Posterior pole photograph. Without pupil dilation. 45° field of view. Modified Davis grading: 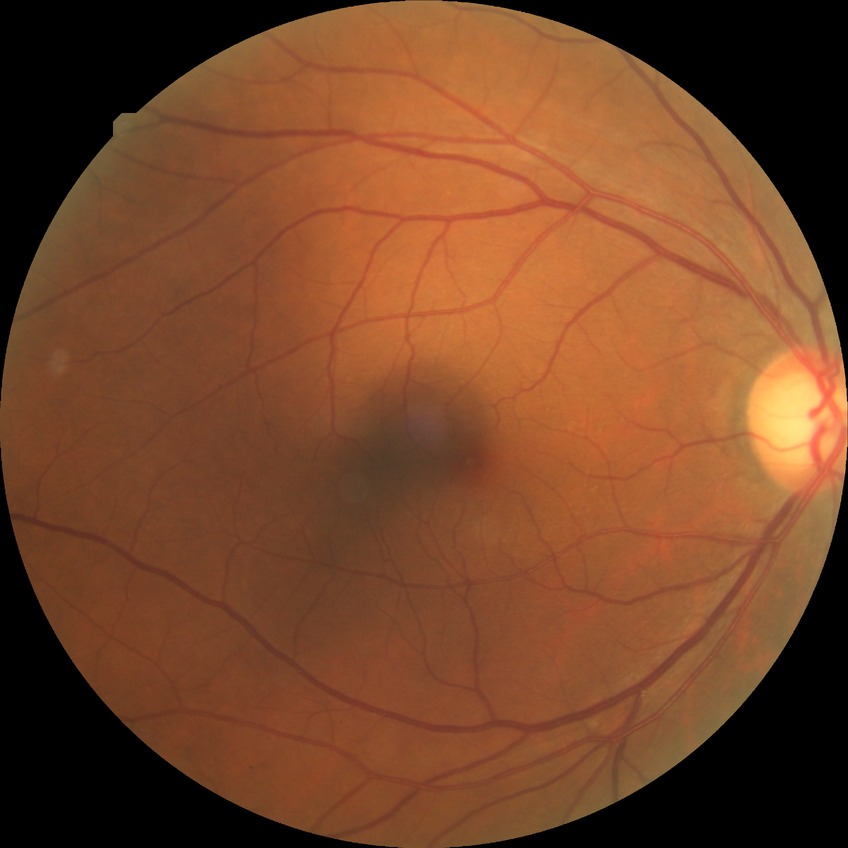 diabetic retinopathy (DR): NDR (no diabetic retinopathy).